2212 by 1659 pixels; FOV: 45 degrees.
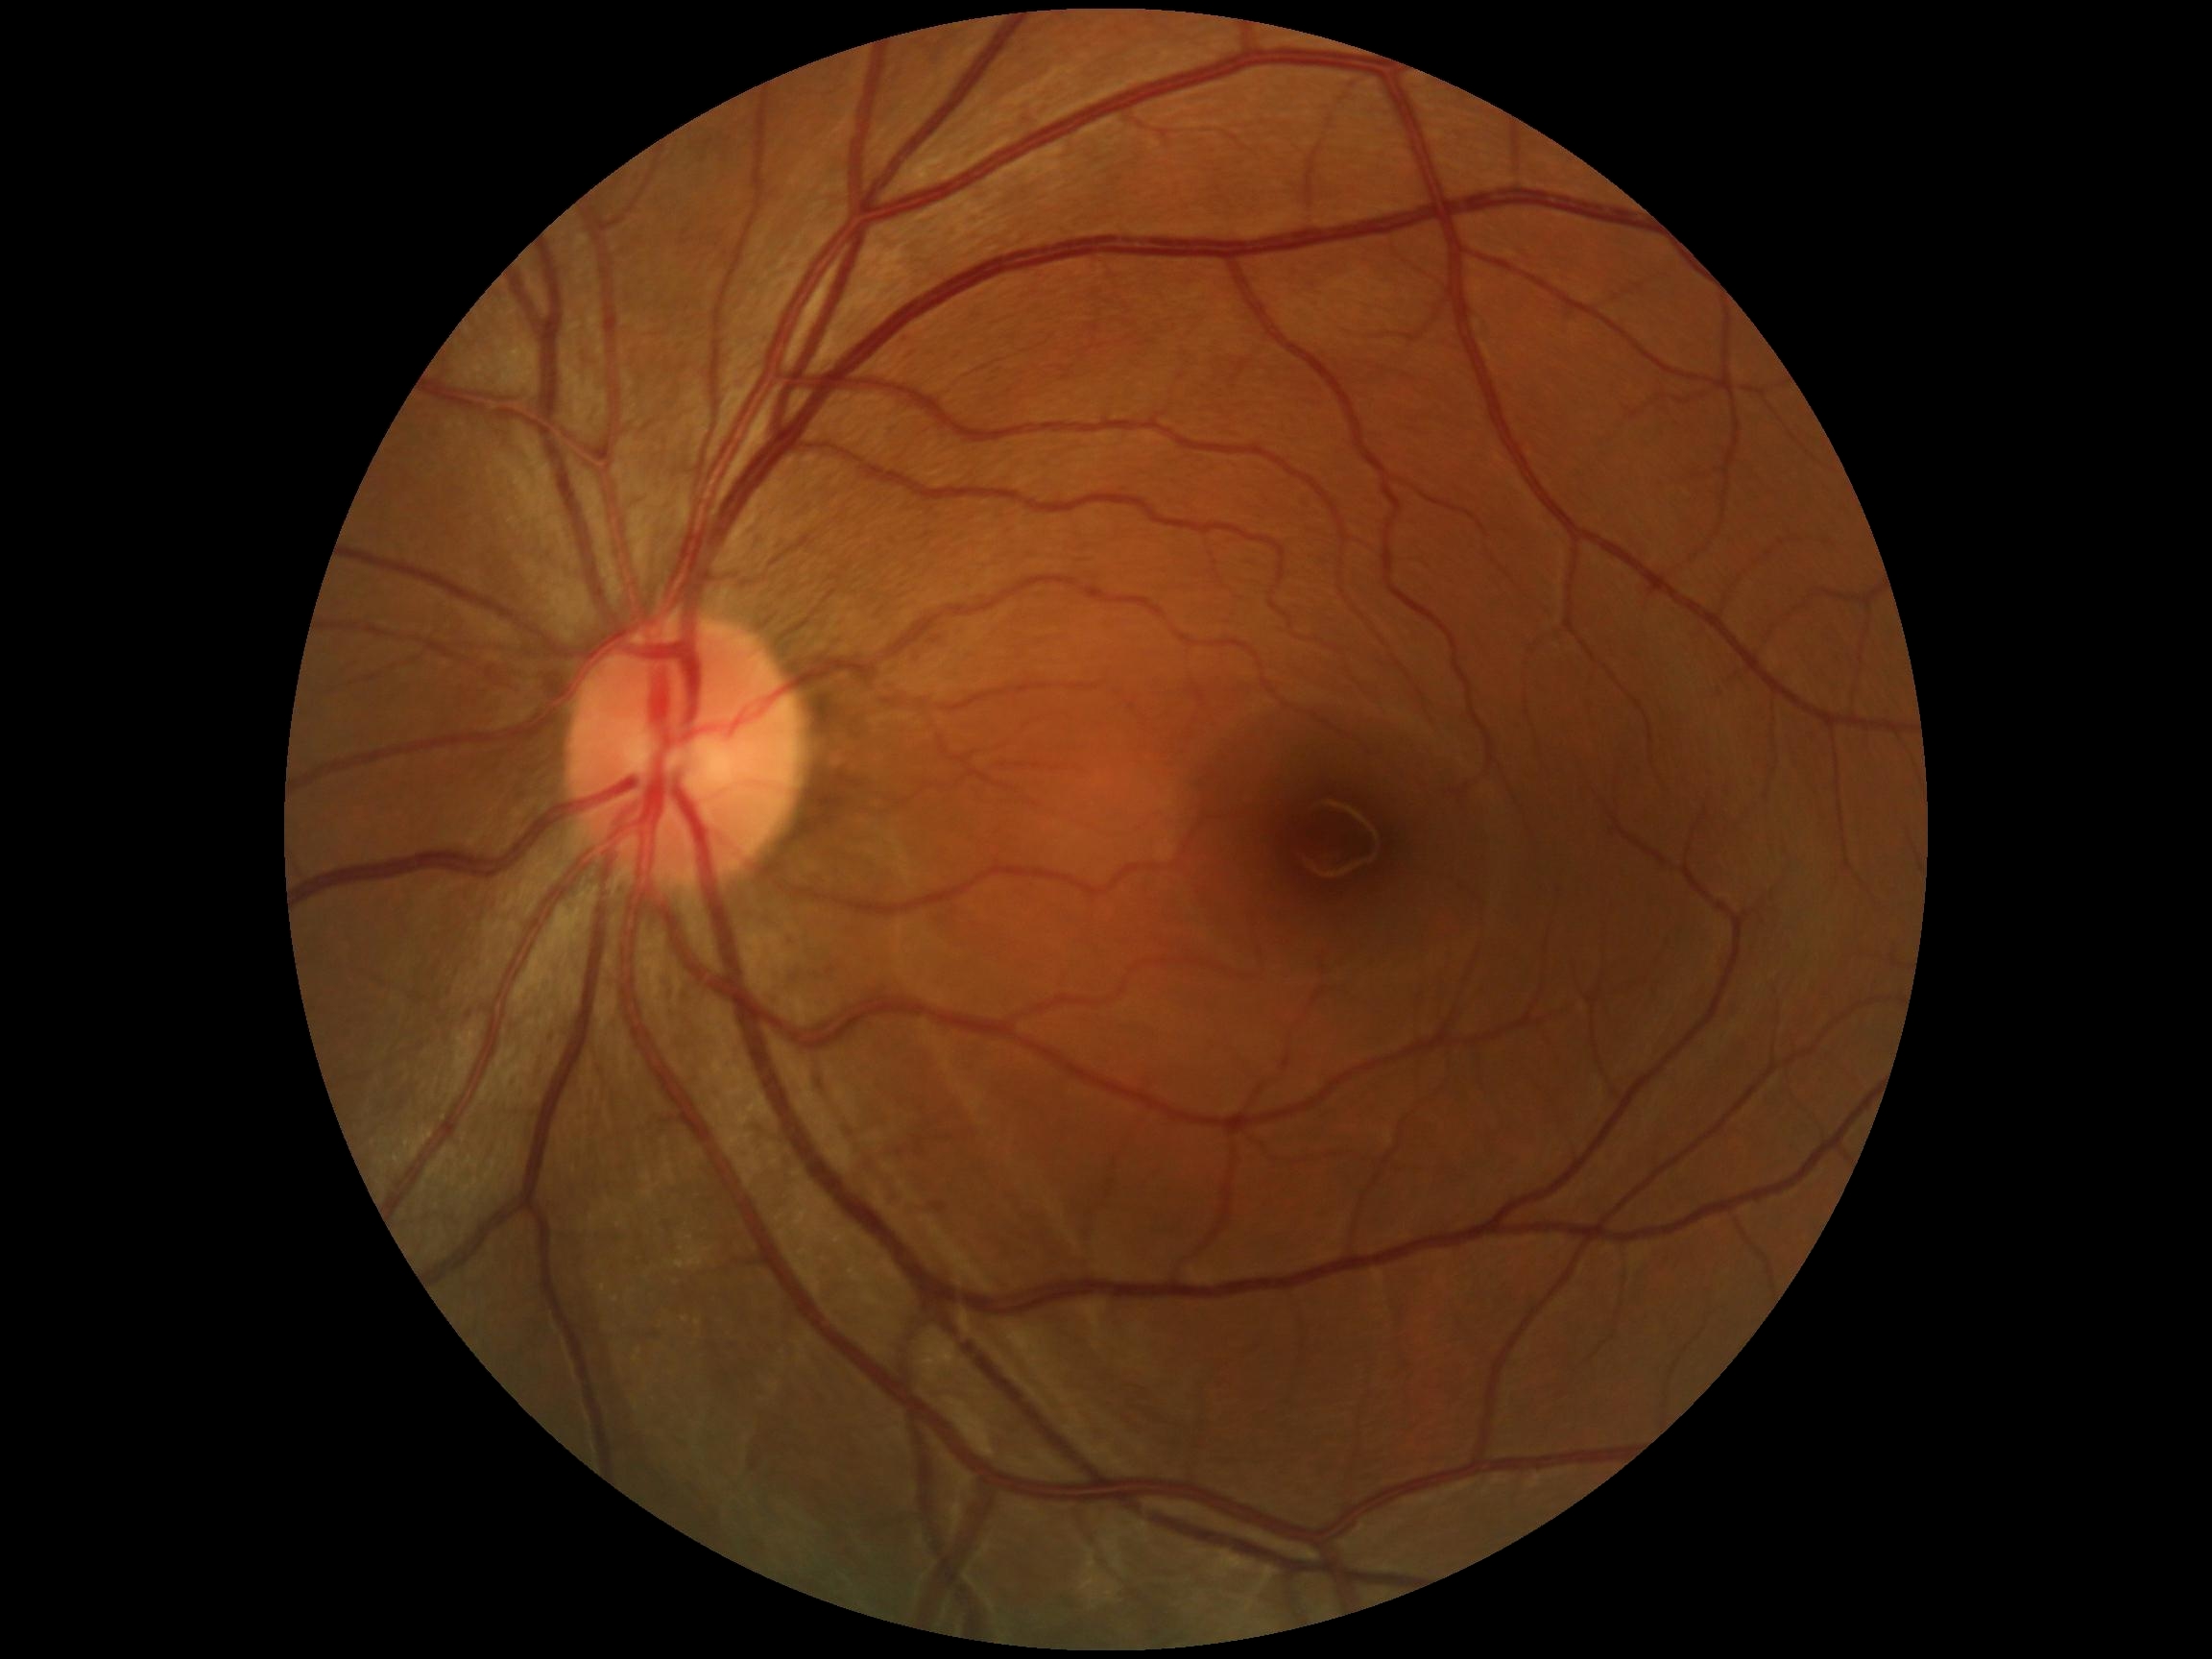 DR stage is grade 0 (no apparent retinopathy). No diabetic retinal disease findings.